Camera: Clarity RetCam 3 (130° FOV) · pediatric retinal photograph (wide-field)
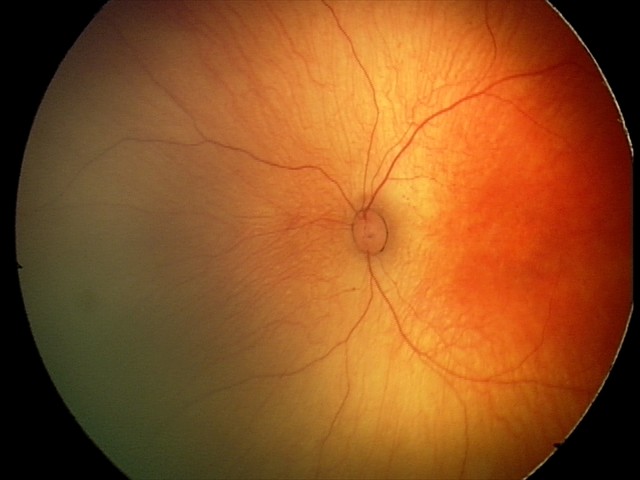
Physiological retinal appearance for postconceptual age.